Retinal fundus photograph.
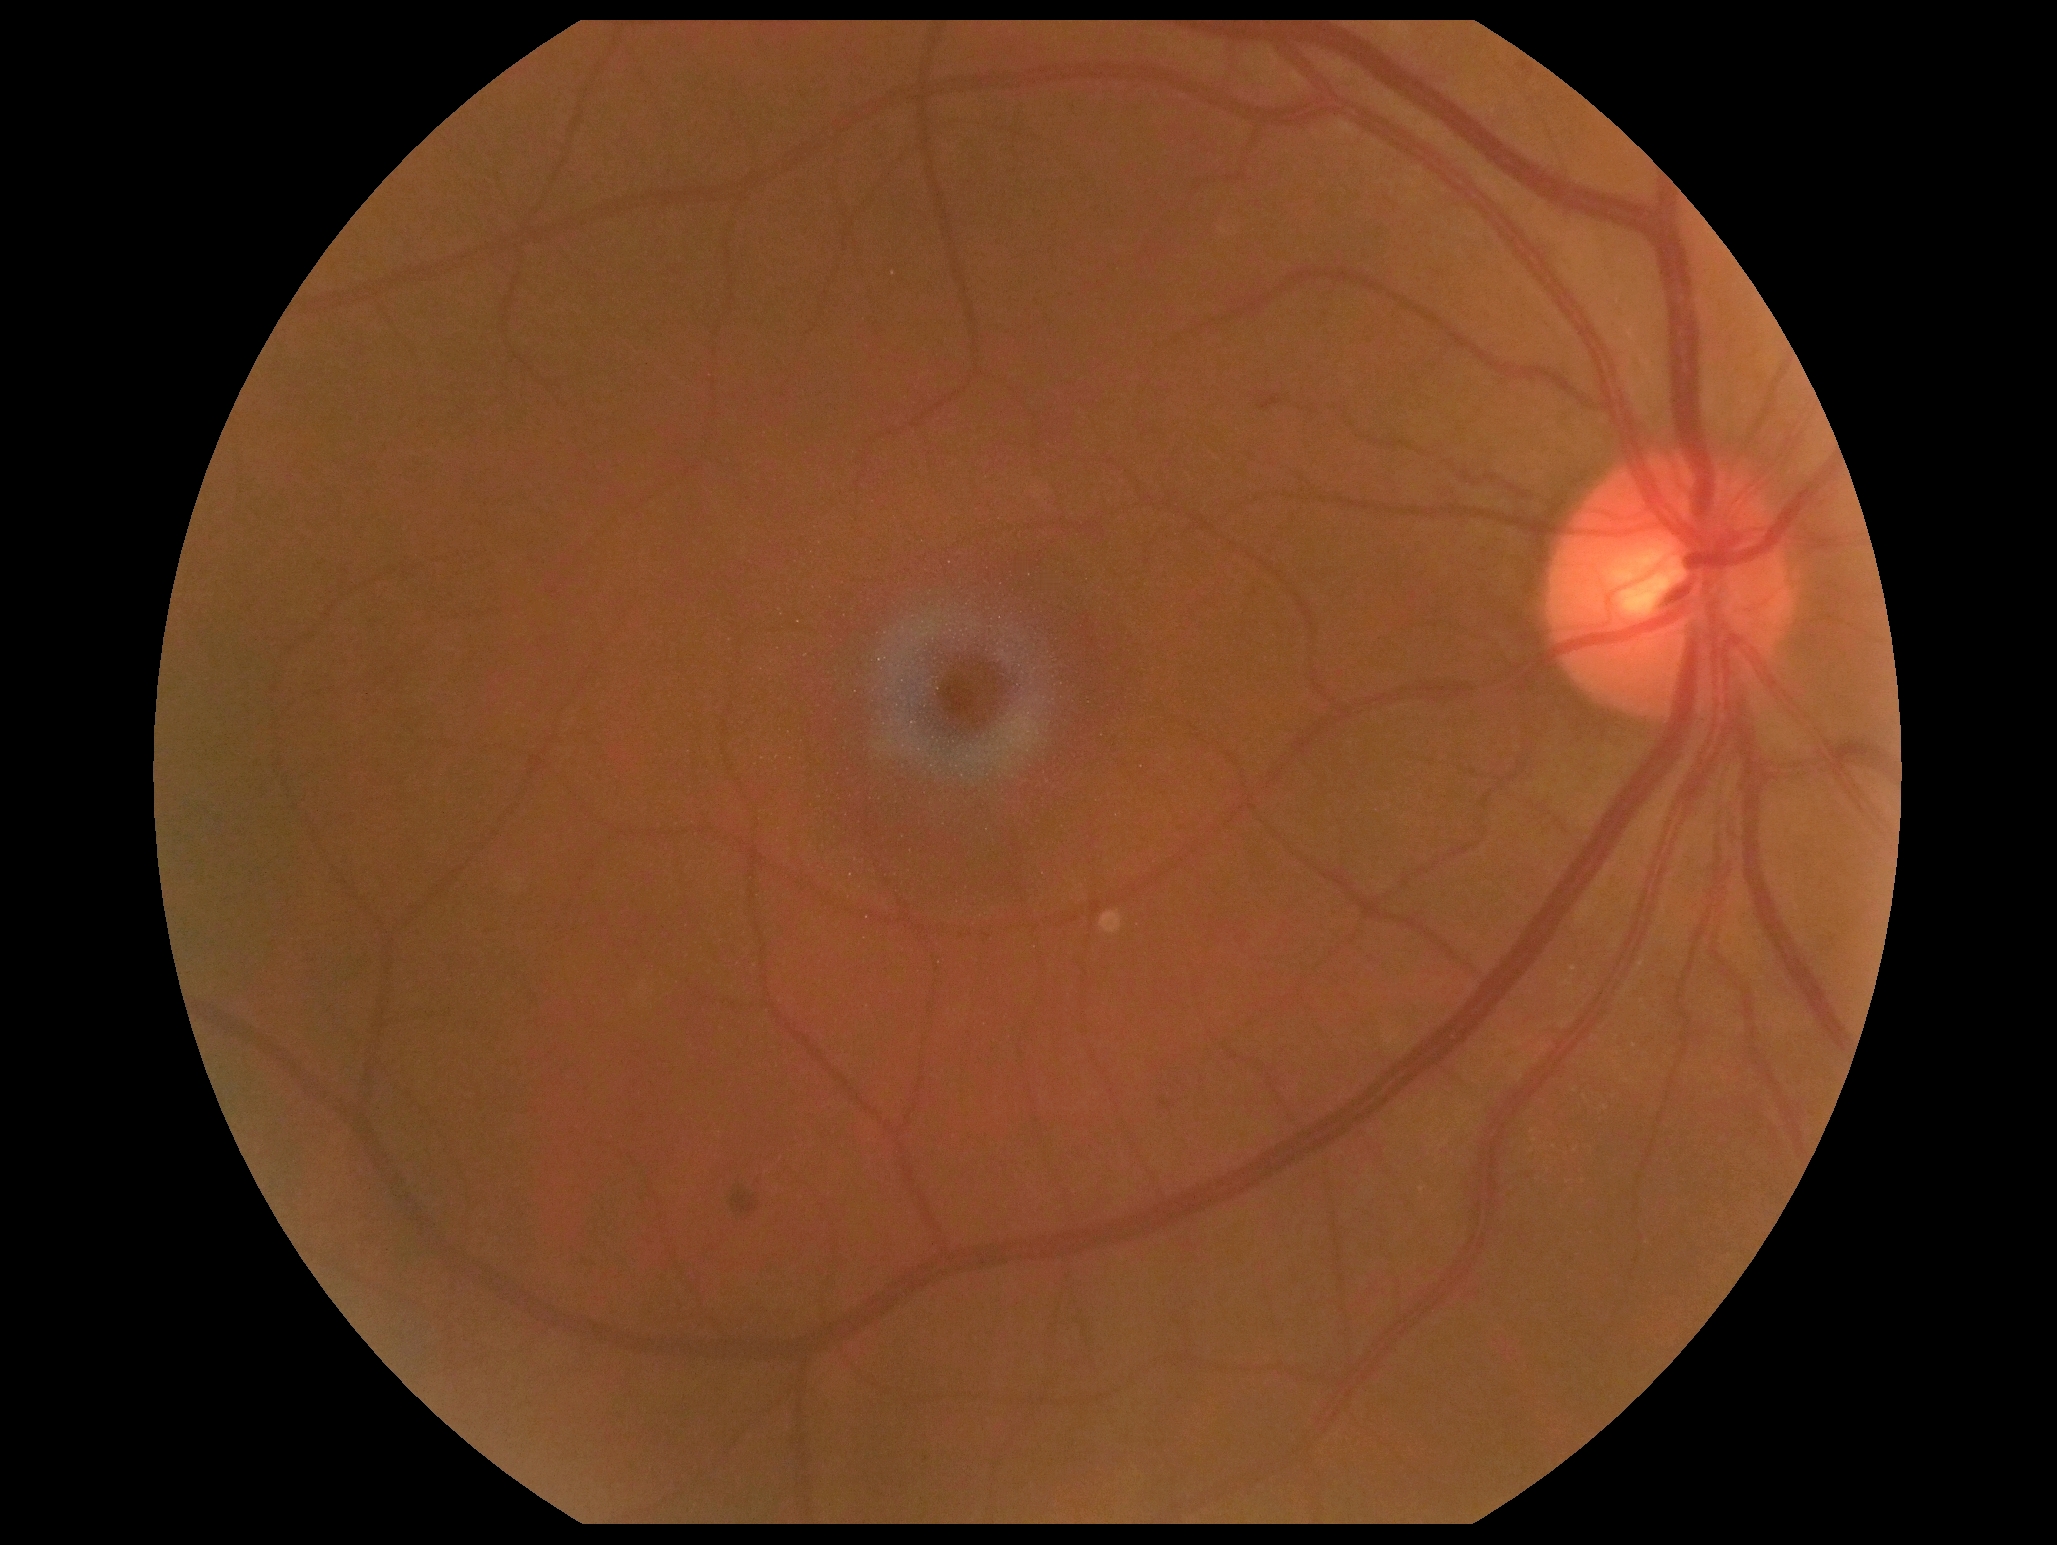
  dr_grade: 2